DR severity per modified Davis staging: 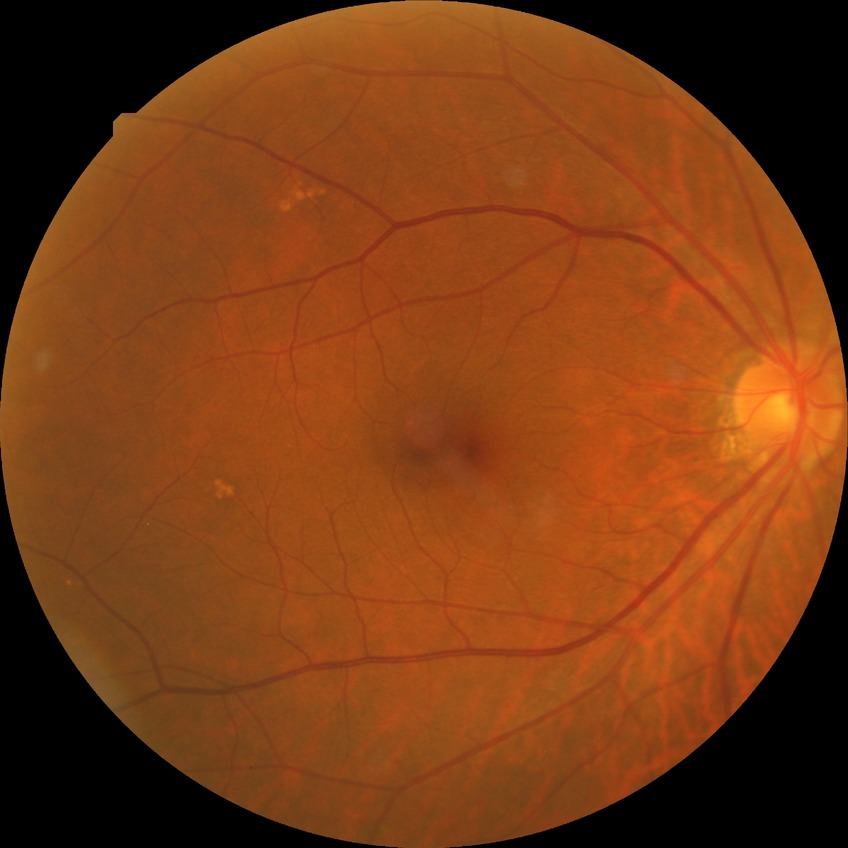 davis_grade: SDR